60° field of view:
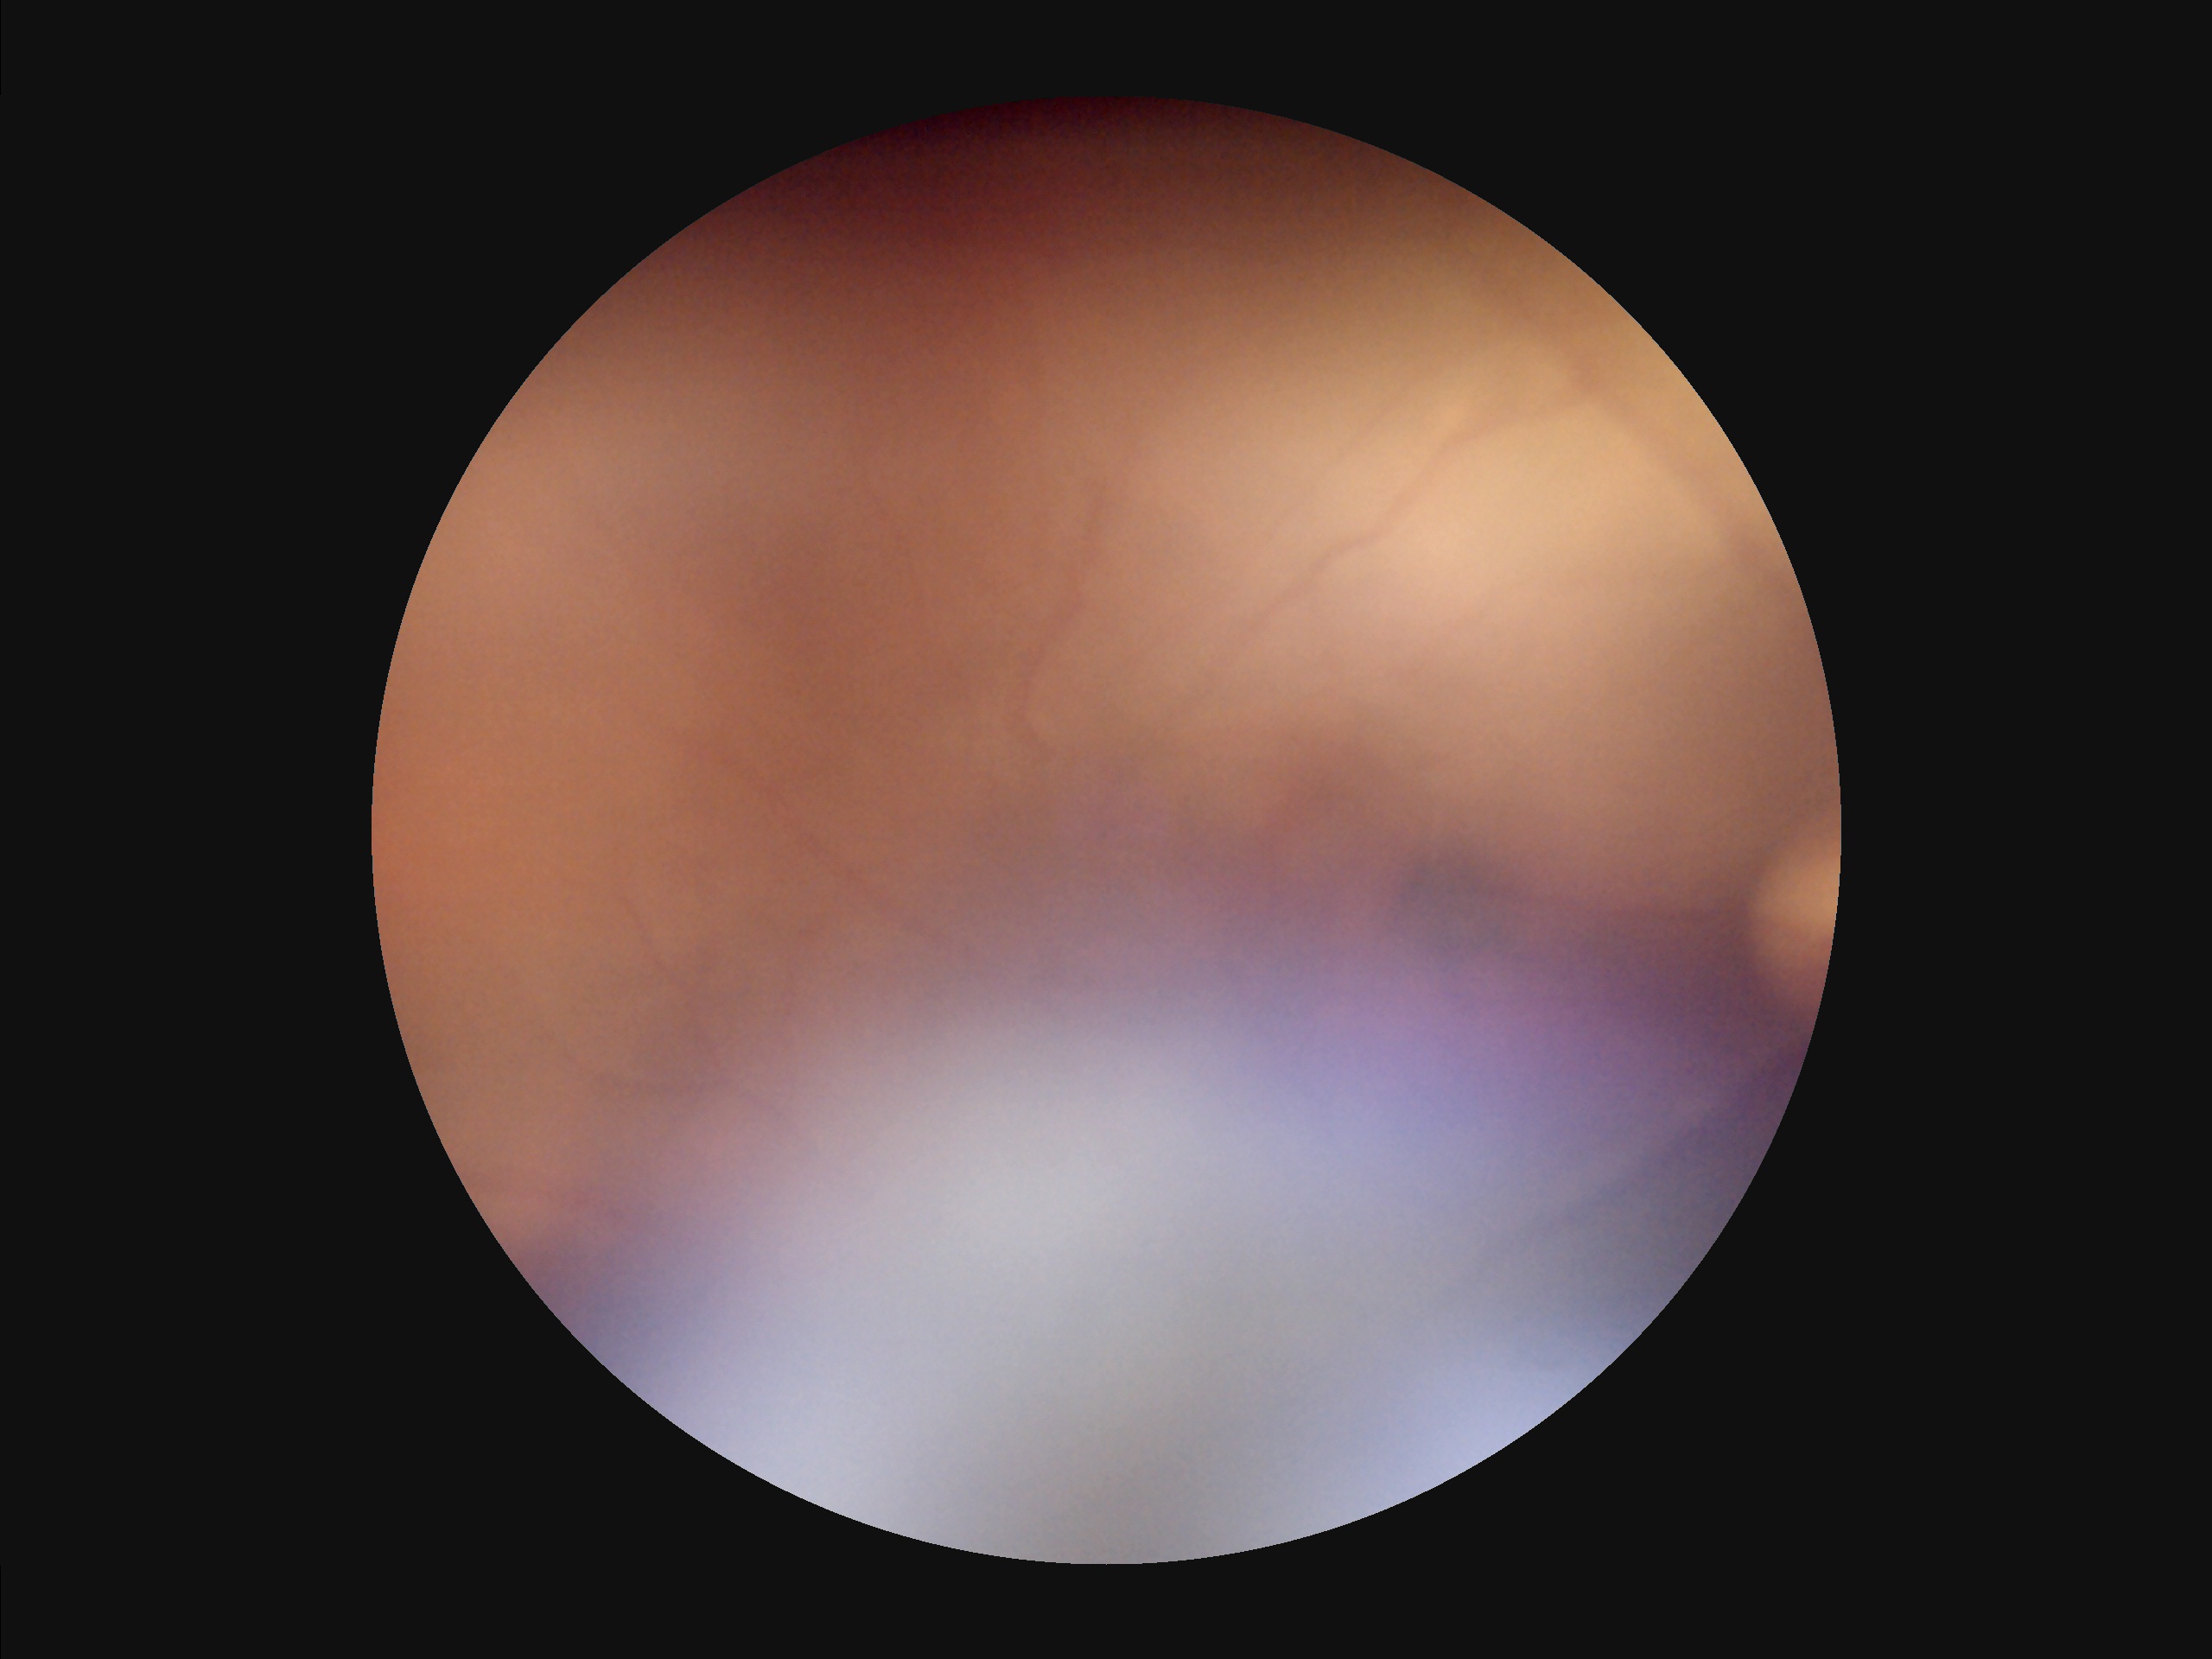 overall_quality: poor and difficult to use diagnostically
clarity: noticeable blur in the optic disc, vessels, or background
illumination: over- or under-exposed
contrast: narrow intensity range, structures hard to distinguish